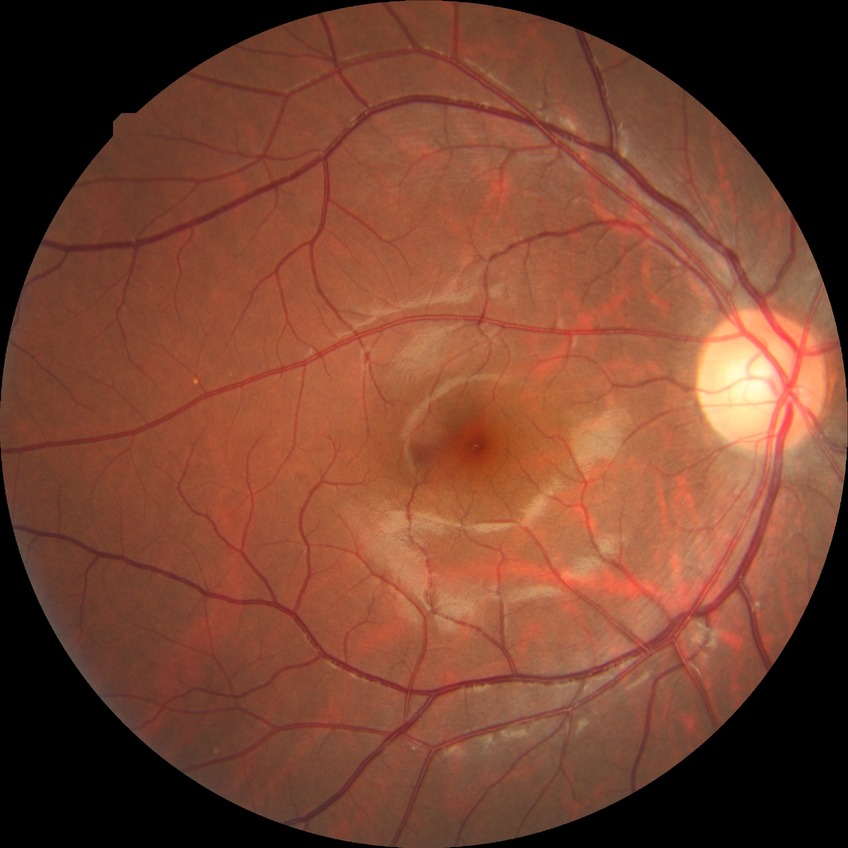
retinopathy grade = no diabetic retinopathy.